Retinal fundus photograph:
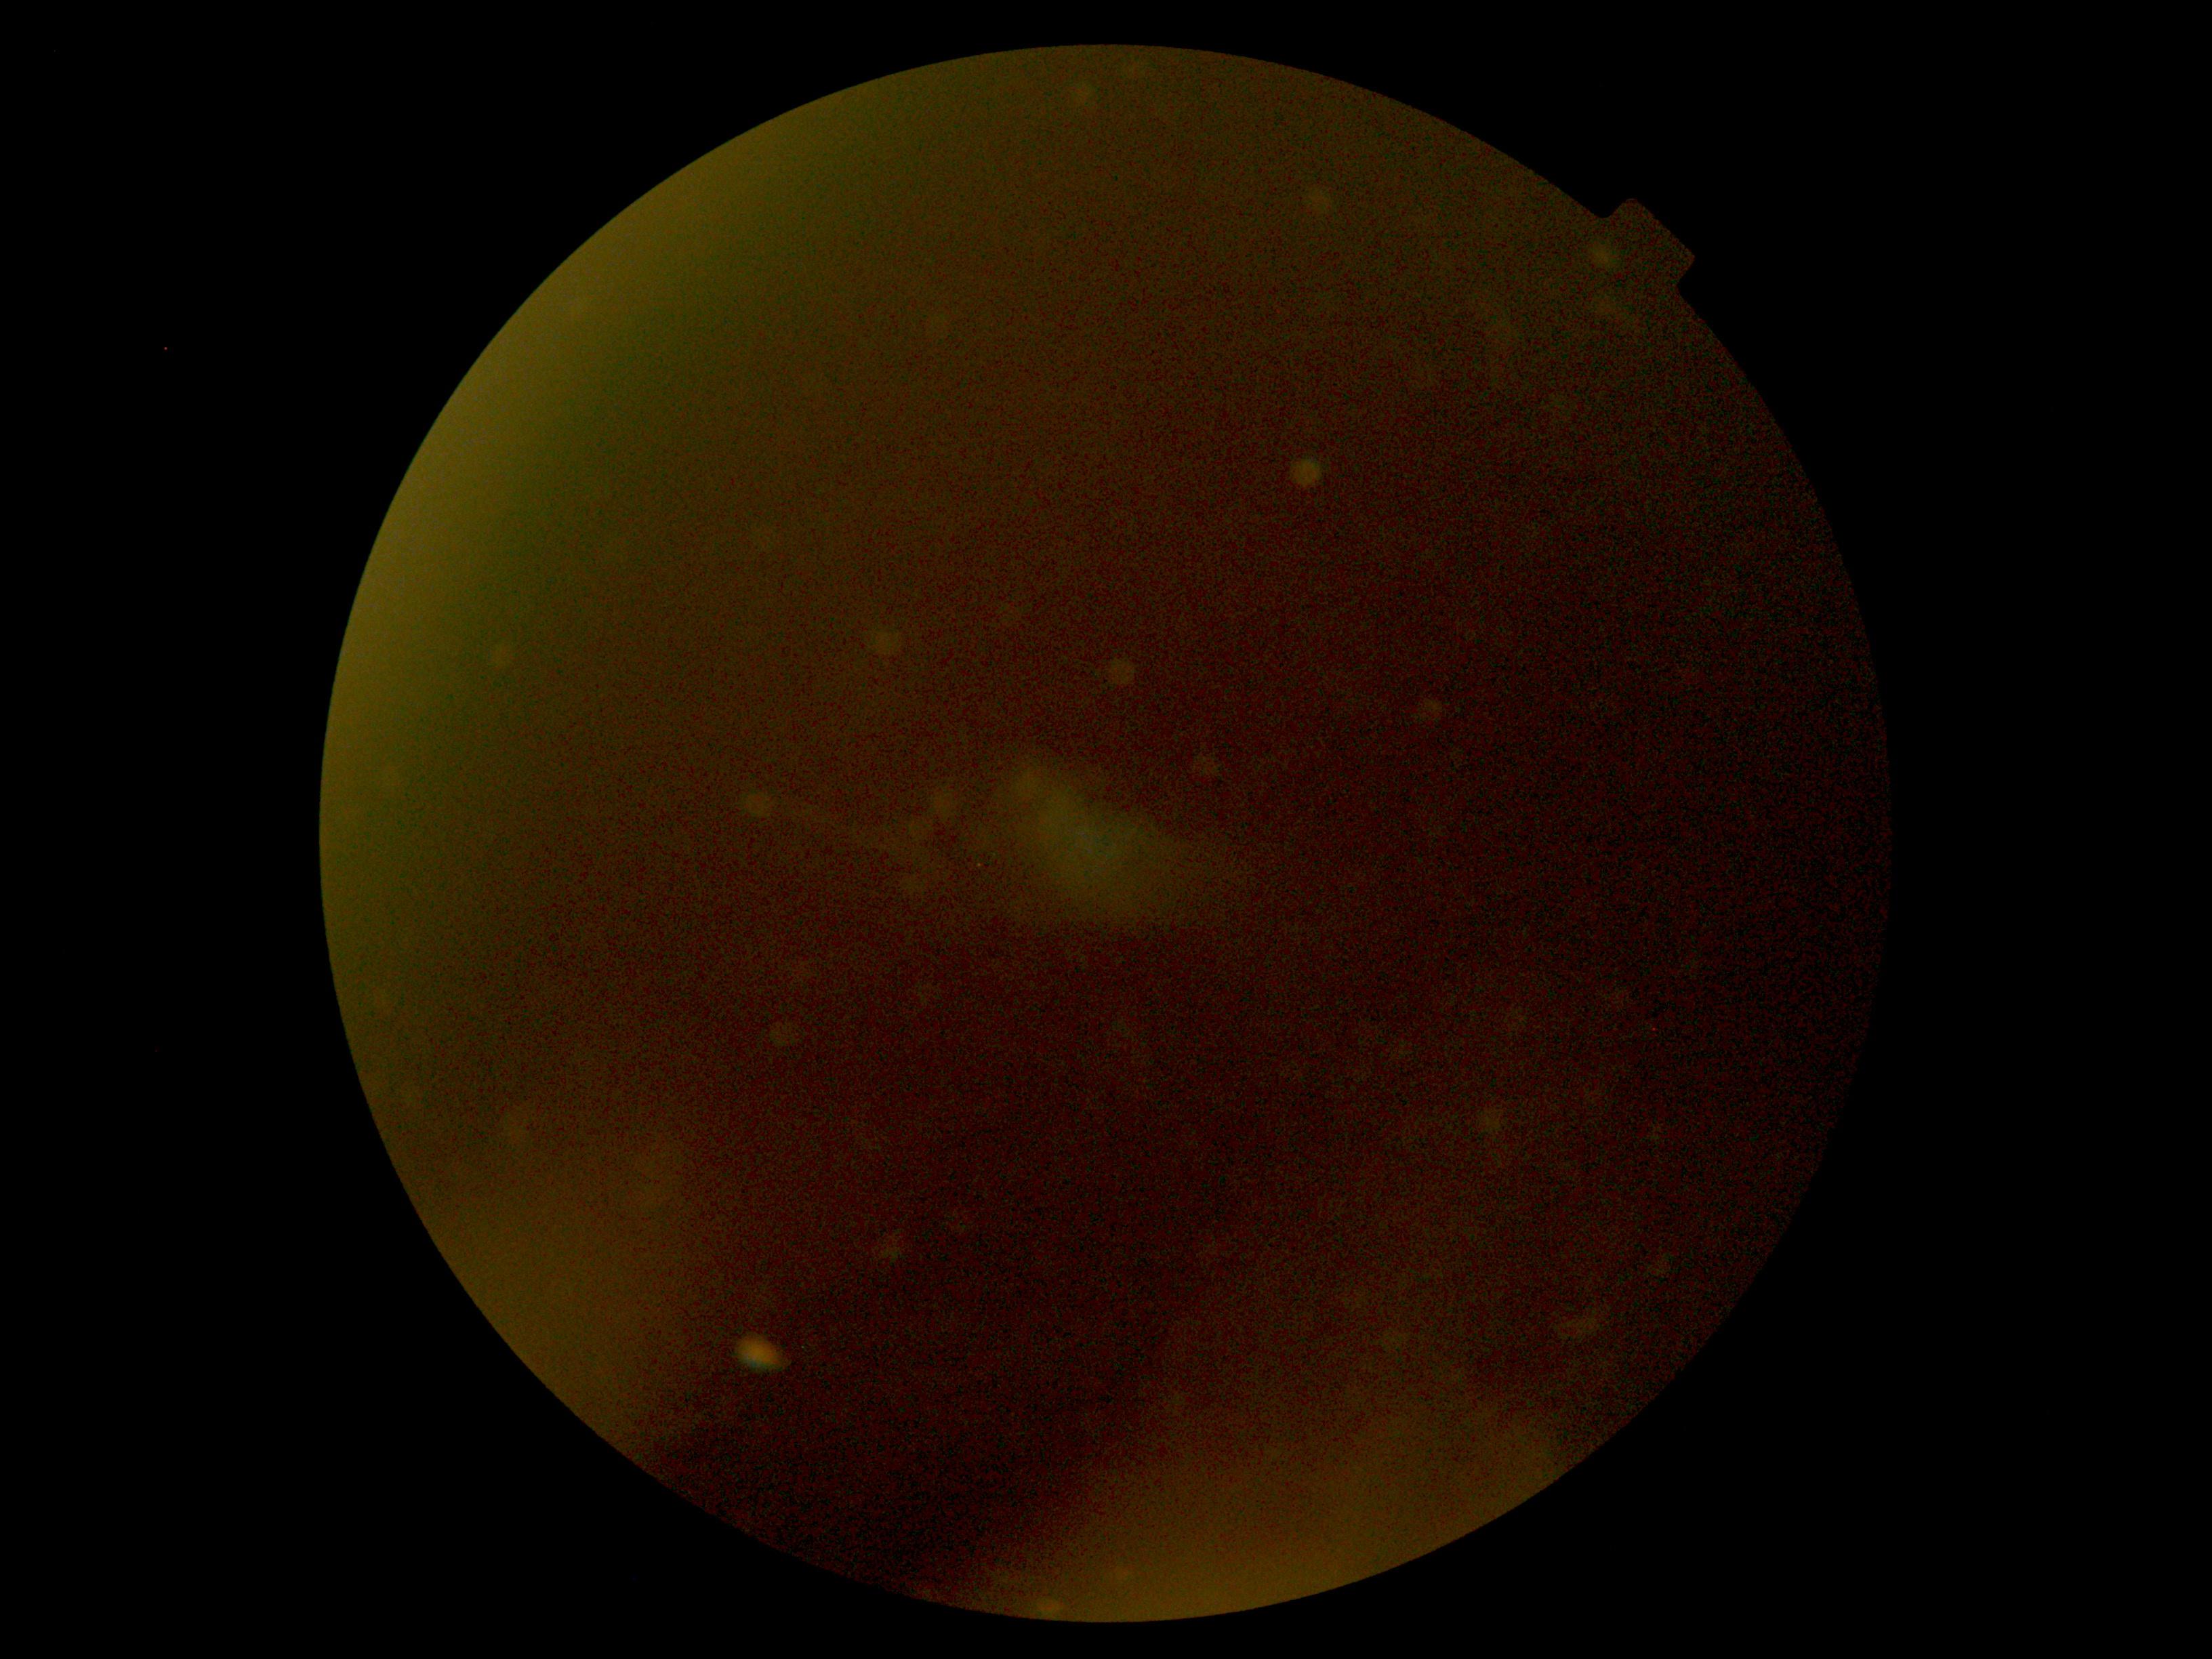

quality: below grading threshold
dr_grade: ungradable